2352x1568px.
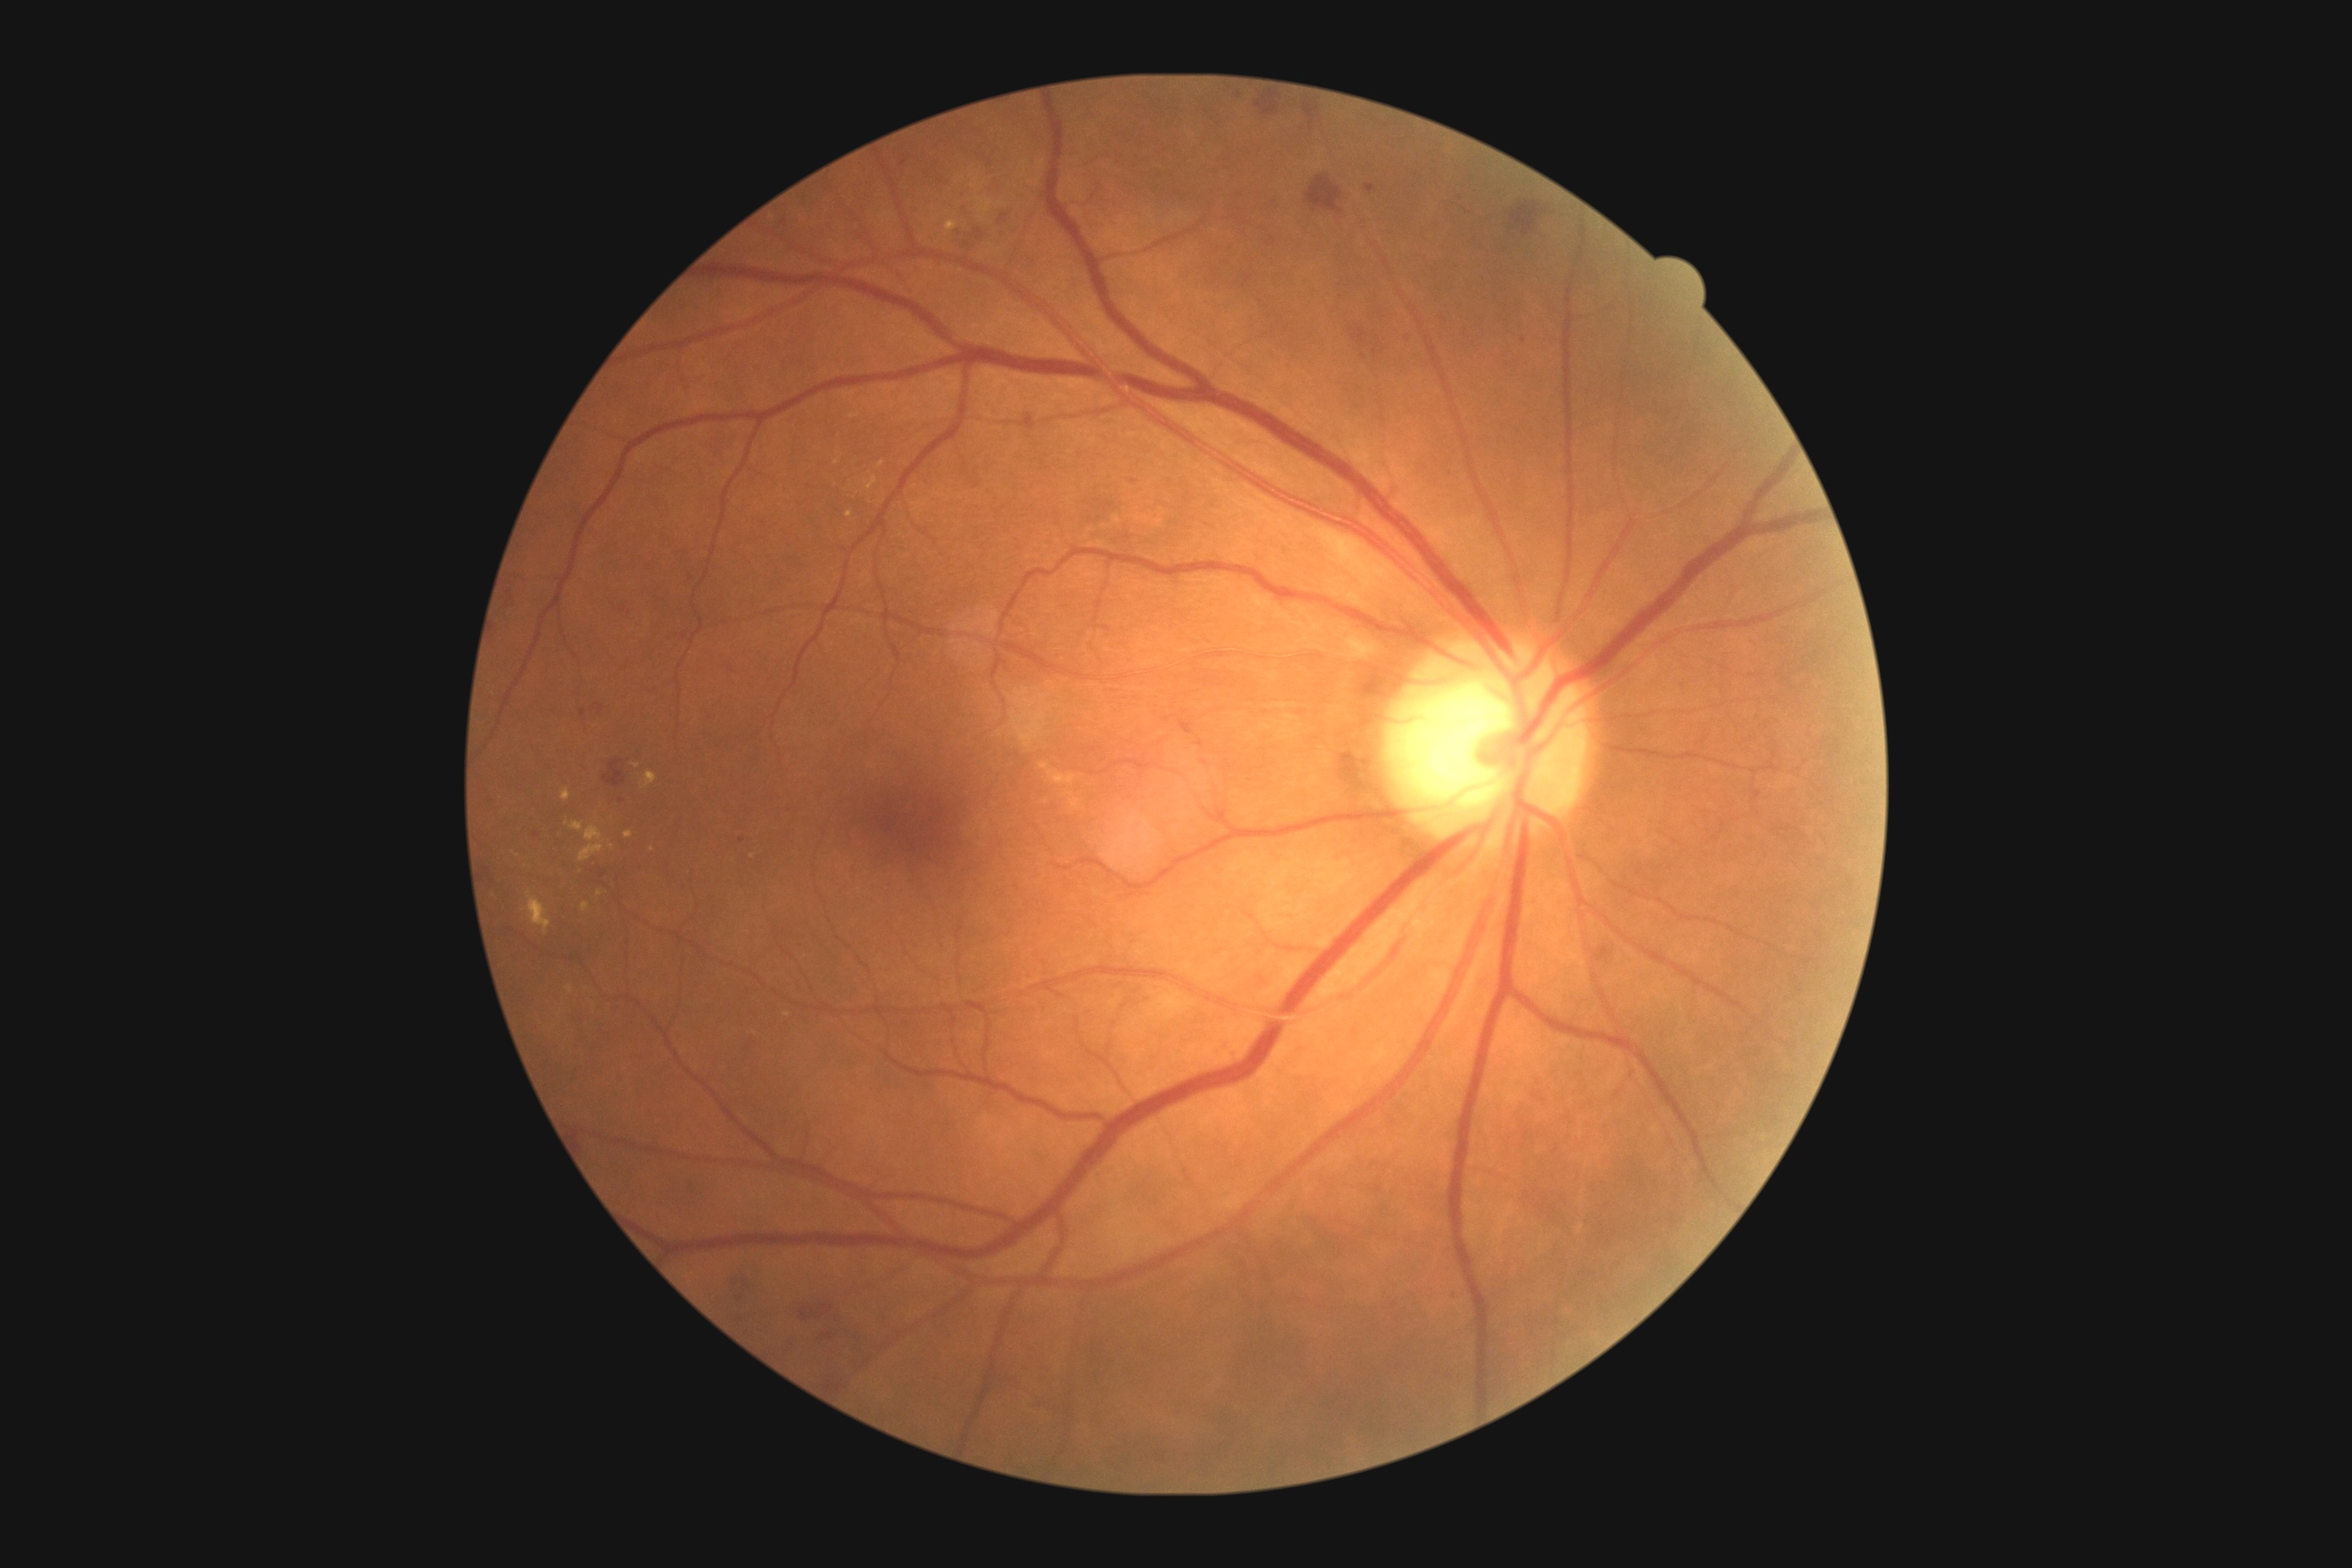
partial: true
dr_grade: 2
dr_grade_name: moderate NPDR
lesions:
  ex:
    - {"x1": 865, "y1": 476, "x2": 877, "y2": 491}
    - {"x1": 571, "y1": 821, "x2": 583, "y2": 832}
    - {"x1": 877, "y1": 462, "x2": 885, "y2": 469}
    - {"x1": 527, "y1": 892, "x2": 553, "y2": 934}
    - {"x1": 567, "y1": 986, "x2": 574, "y2": 995}
    - {"x1": 625, "y1": 830, "x2": 634, "y2": 839}
    - {"x1": 585, "y1": 825, "x2": 603, "y2": 843}
  ex_small_centers:
    - point(637, 767)
    - point(849, 514)
    - point(567, 823)
    - point(756, 1033)
  ma: []
  he:
    - {"x1": 505, "y1": 591, "x2": 518, "y2": 609}
    - {"x1": 995, "y1": 230, "x2": 1008, "y2": 239}
    - {"x1": 1302, "y1": 101, "x2": 1324, "y2": 139}
    - {"x1": 698, "y1": 730, "x2": 714, "y2": 741}
    - {"x1": 582, "y1": 710, "x2": 587, "y2": 718}
    - {"x1": 727, "y1": 1141, "x2": 750, "y2": 1153}
    - {"x1": 1308, "y1": 177, "x2": 1344, "y2": 215}
    - {"x1": 789, "y1": 1298, "x2": 863, "y2": 1346}
    - {"x1": 1398, "y1": 329, "x2": 1420, "y2": 346}
    - {"x1": 643, "y1": 1110, "x2": 654, "y2": 1119}
    - {"x1": 936, "y1": 260, "x2": 943, "y2": 271}
    - {"x1": 485, "y1": 867, "x2": 491, "y2": 877}
    - {"x1": 603, "y1": 760, "x2": 625, "y2": 789}
    - {"x1": 625, "y1": 1052, "x2": 647, "y2": 1064}
  he_small_centers:
    - point(537, 835)
    - point(1134, 482)
    - point(1524, 341)
  se: []